Fundus photo, 2352 by 1568 pixels, FOV: 45 degrees — 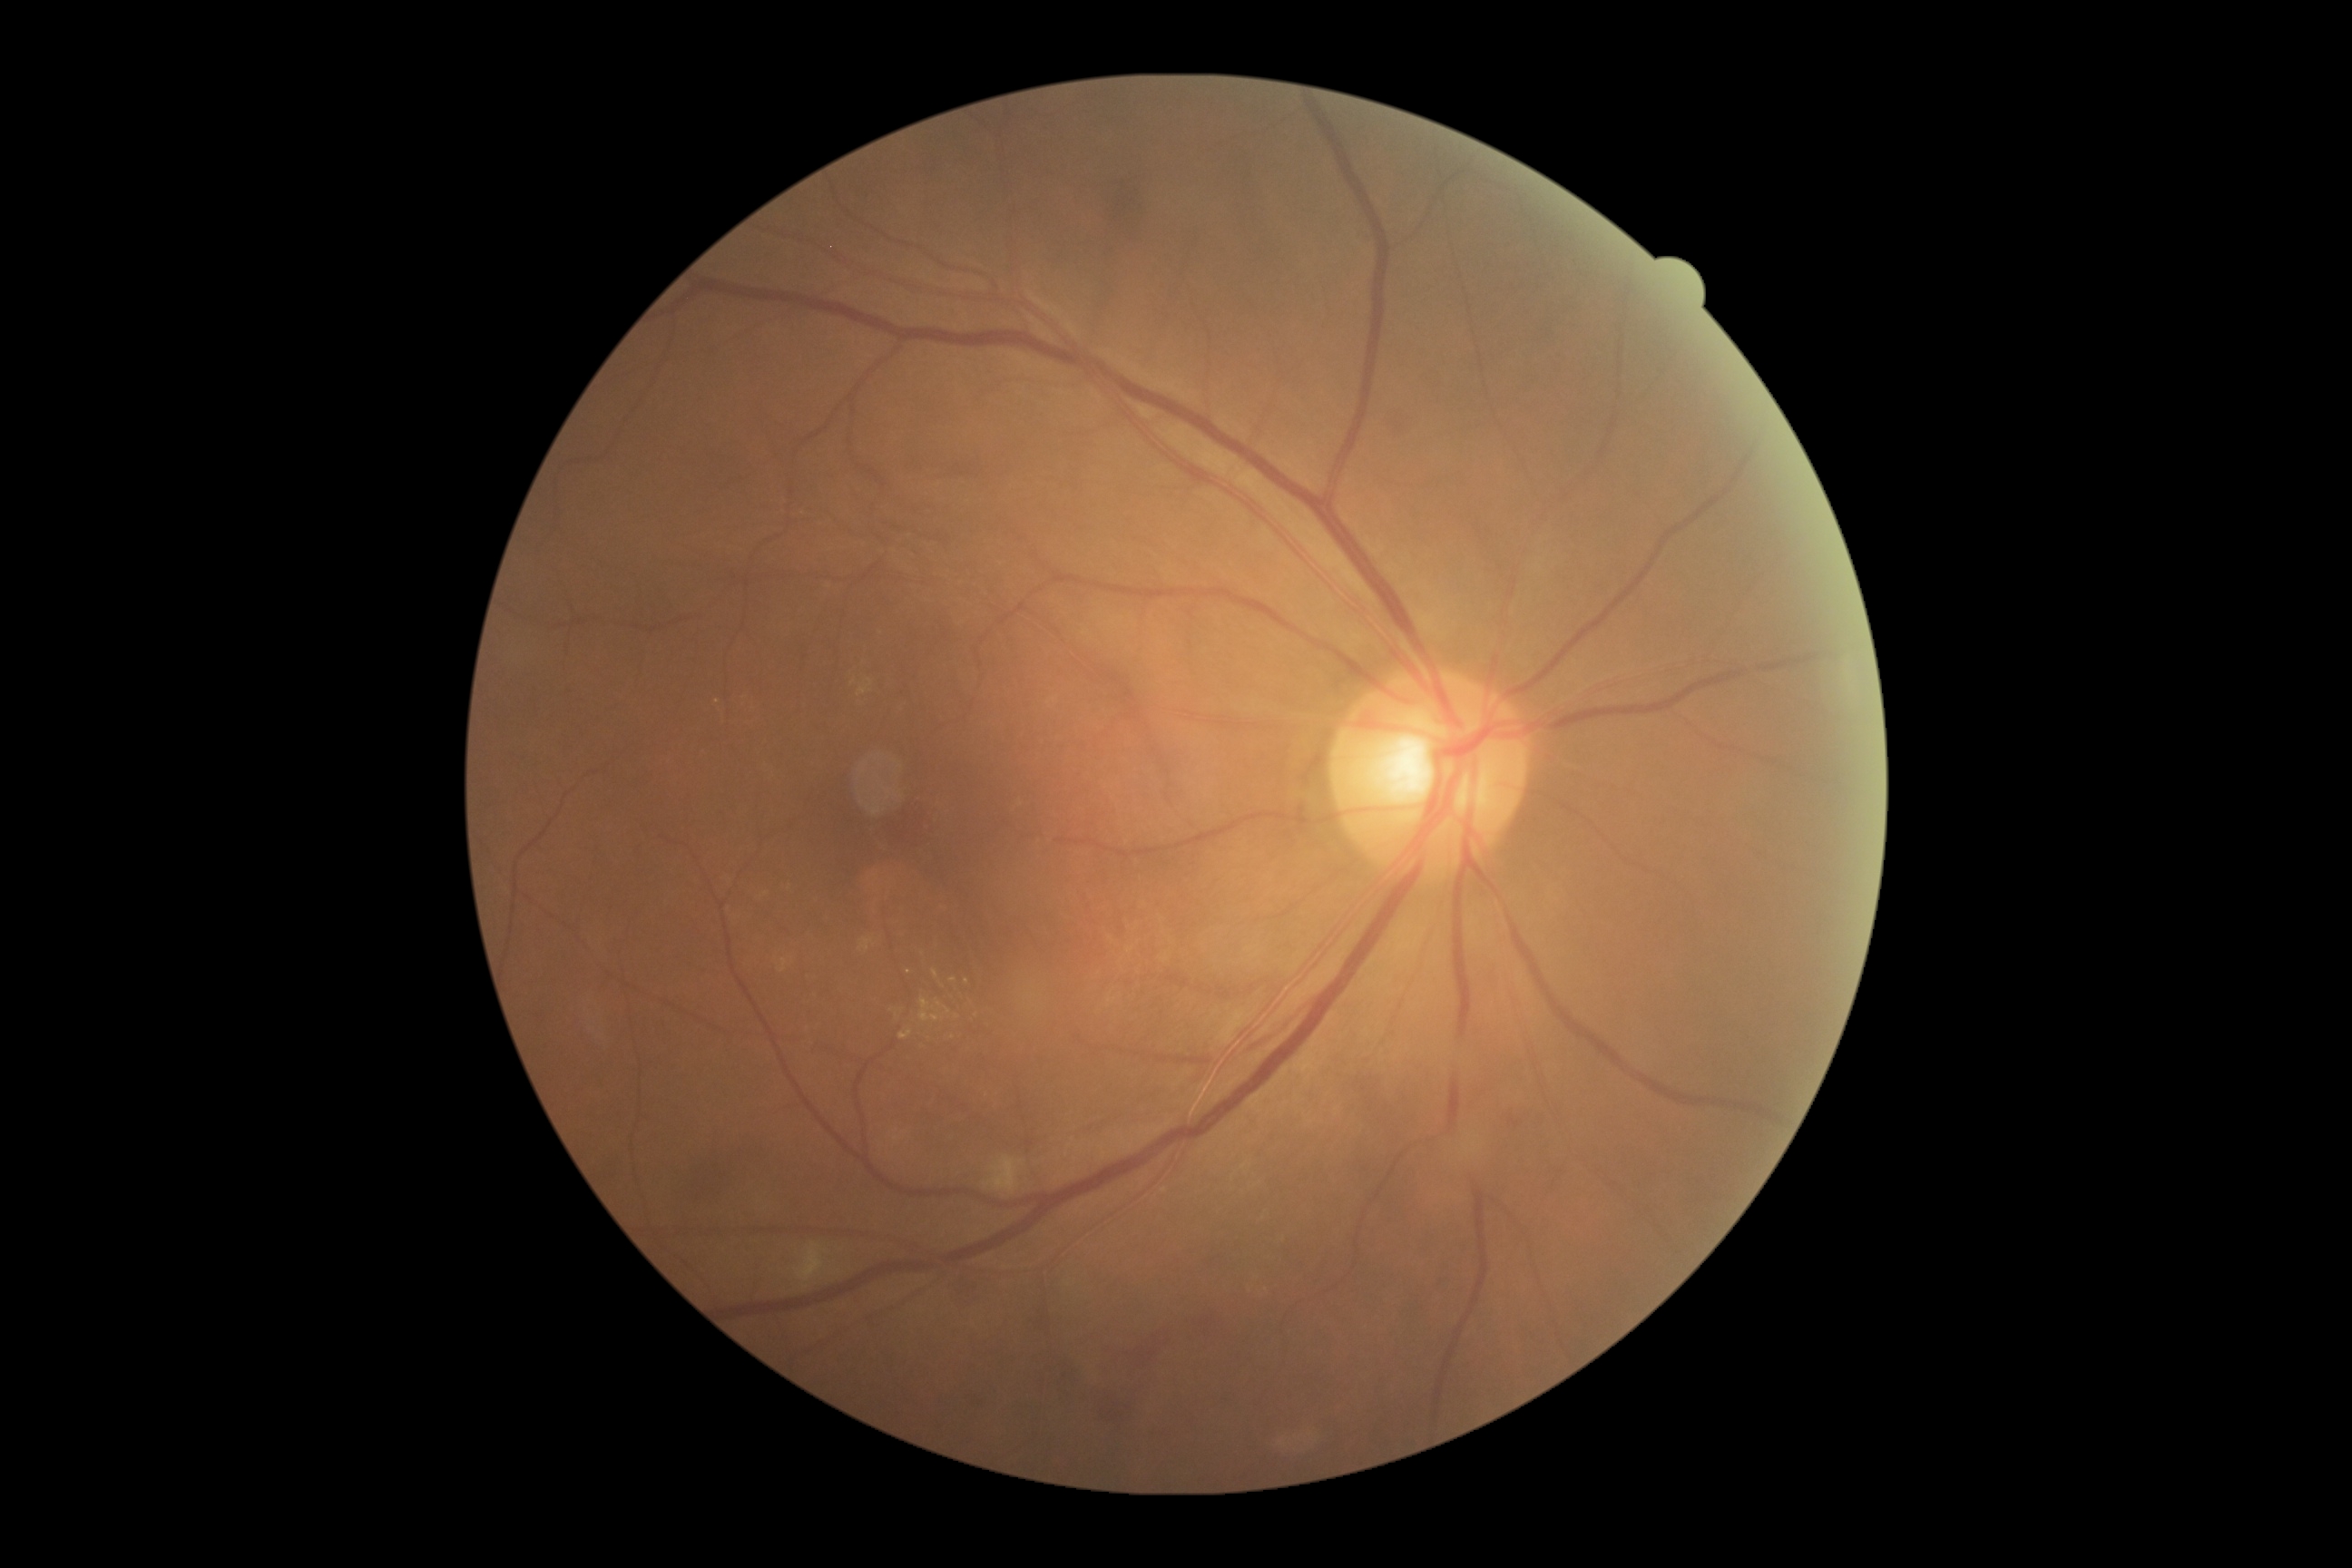

DR: grade 2 (moderate NPDR).